Color fundus photograph, 45° FOV
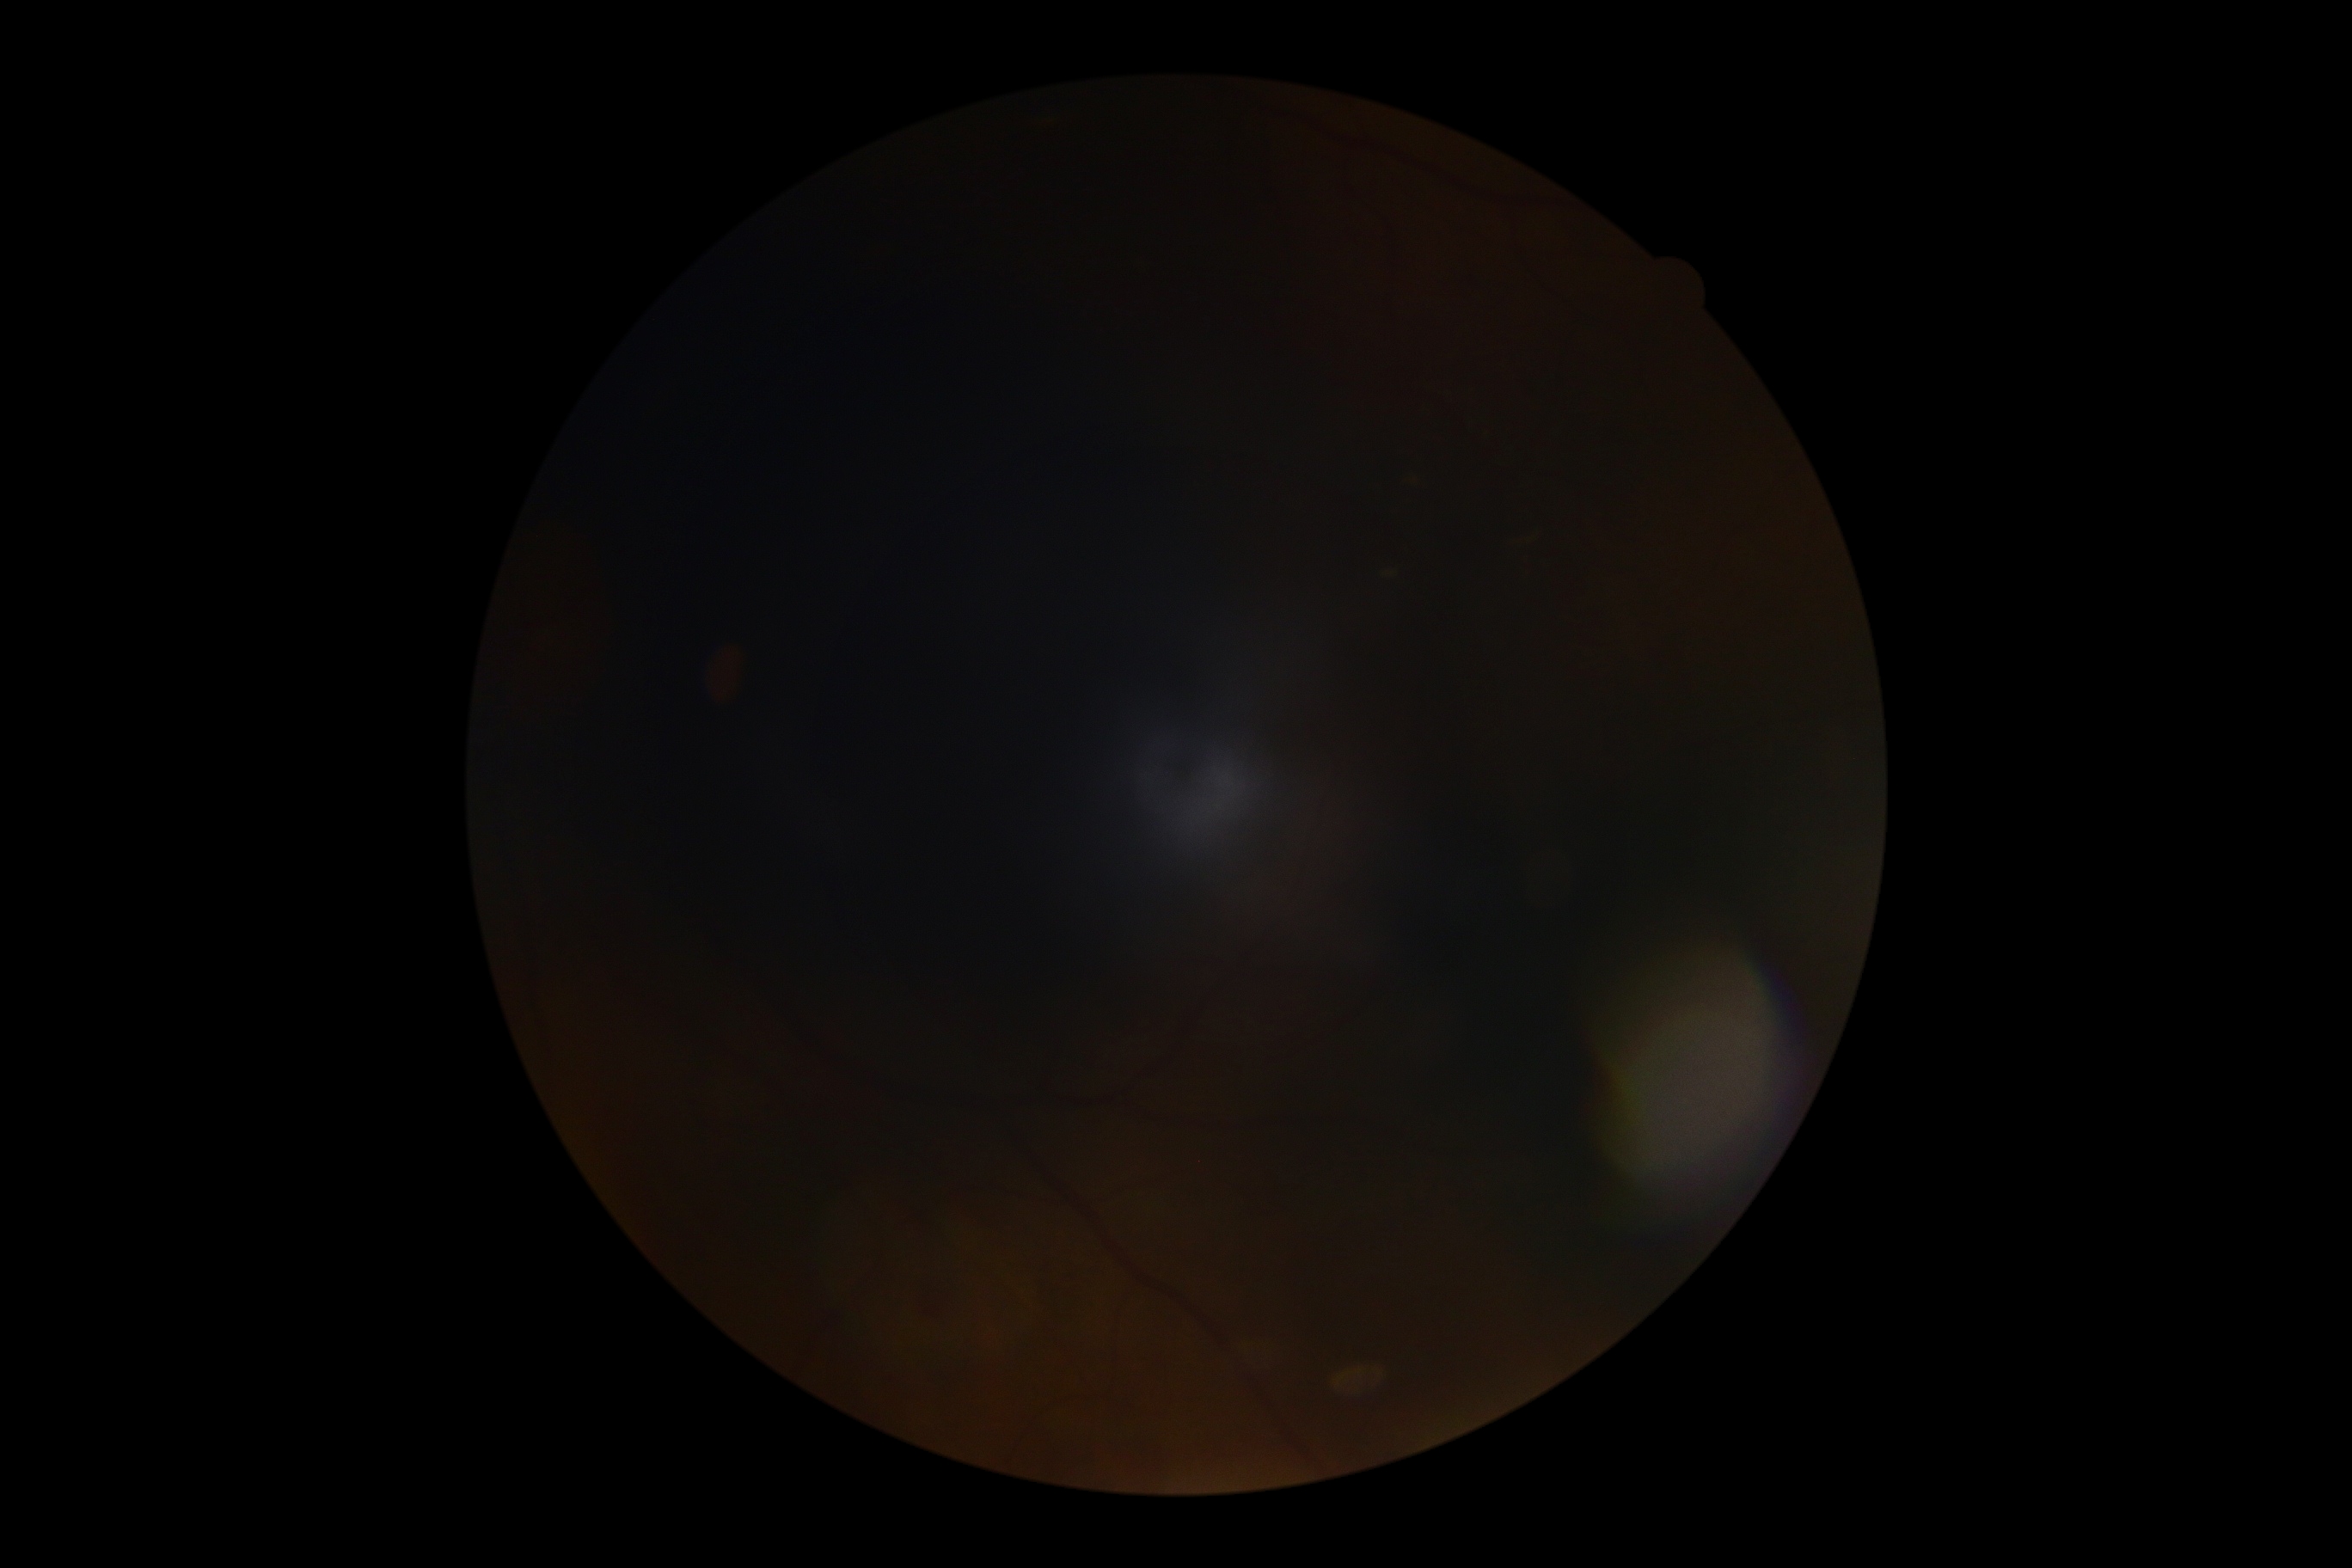
Diabetic retinopathy (DR): ungradable due to poor image quality.